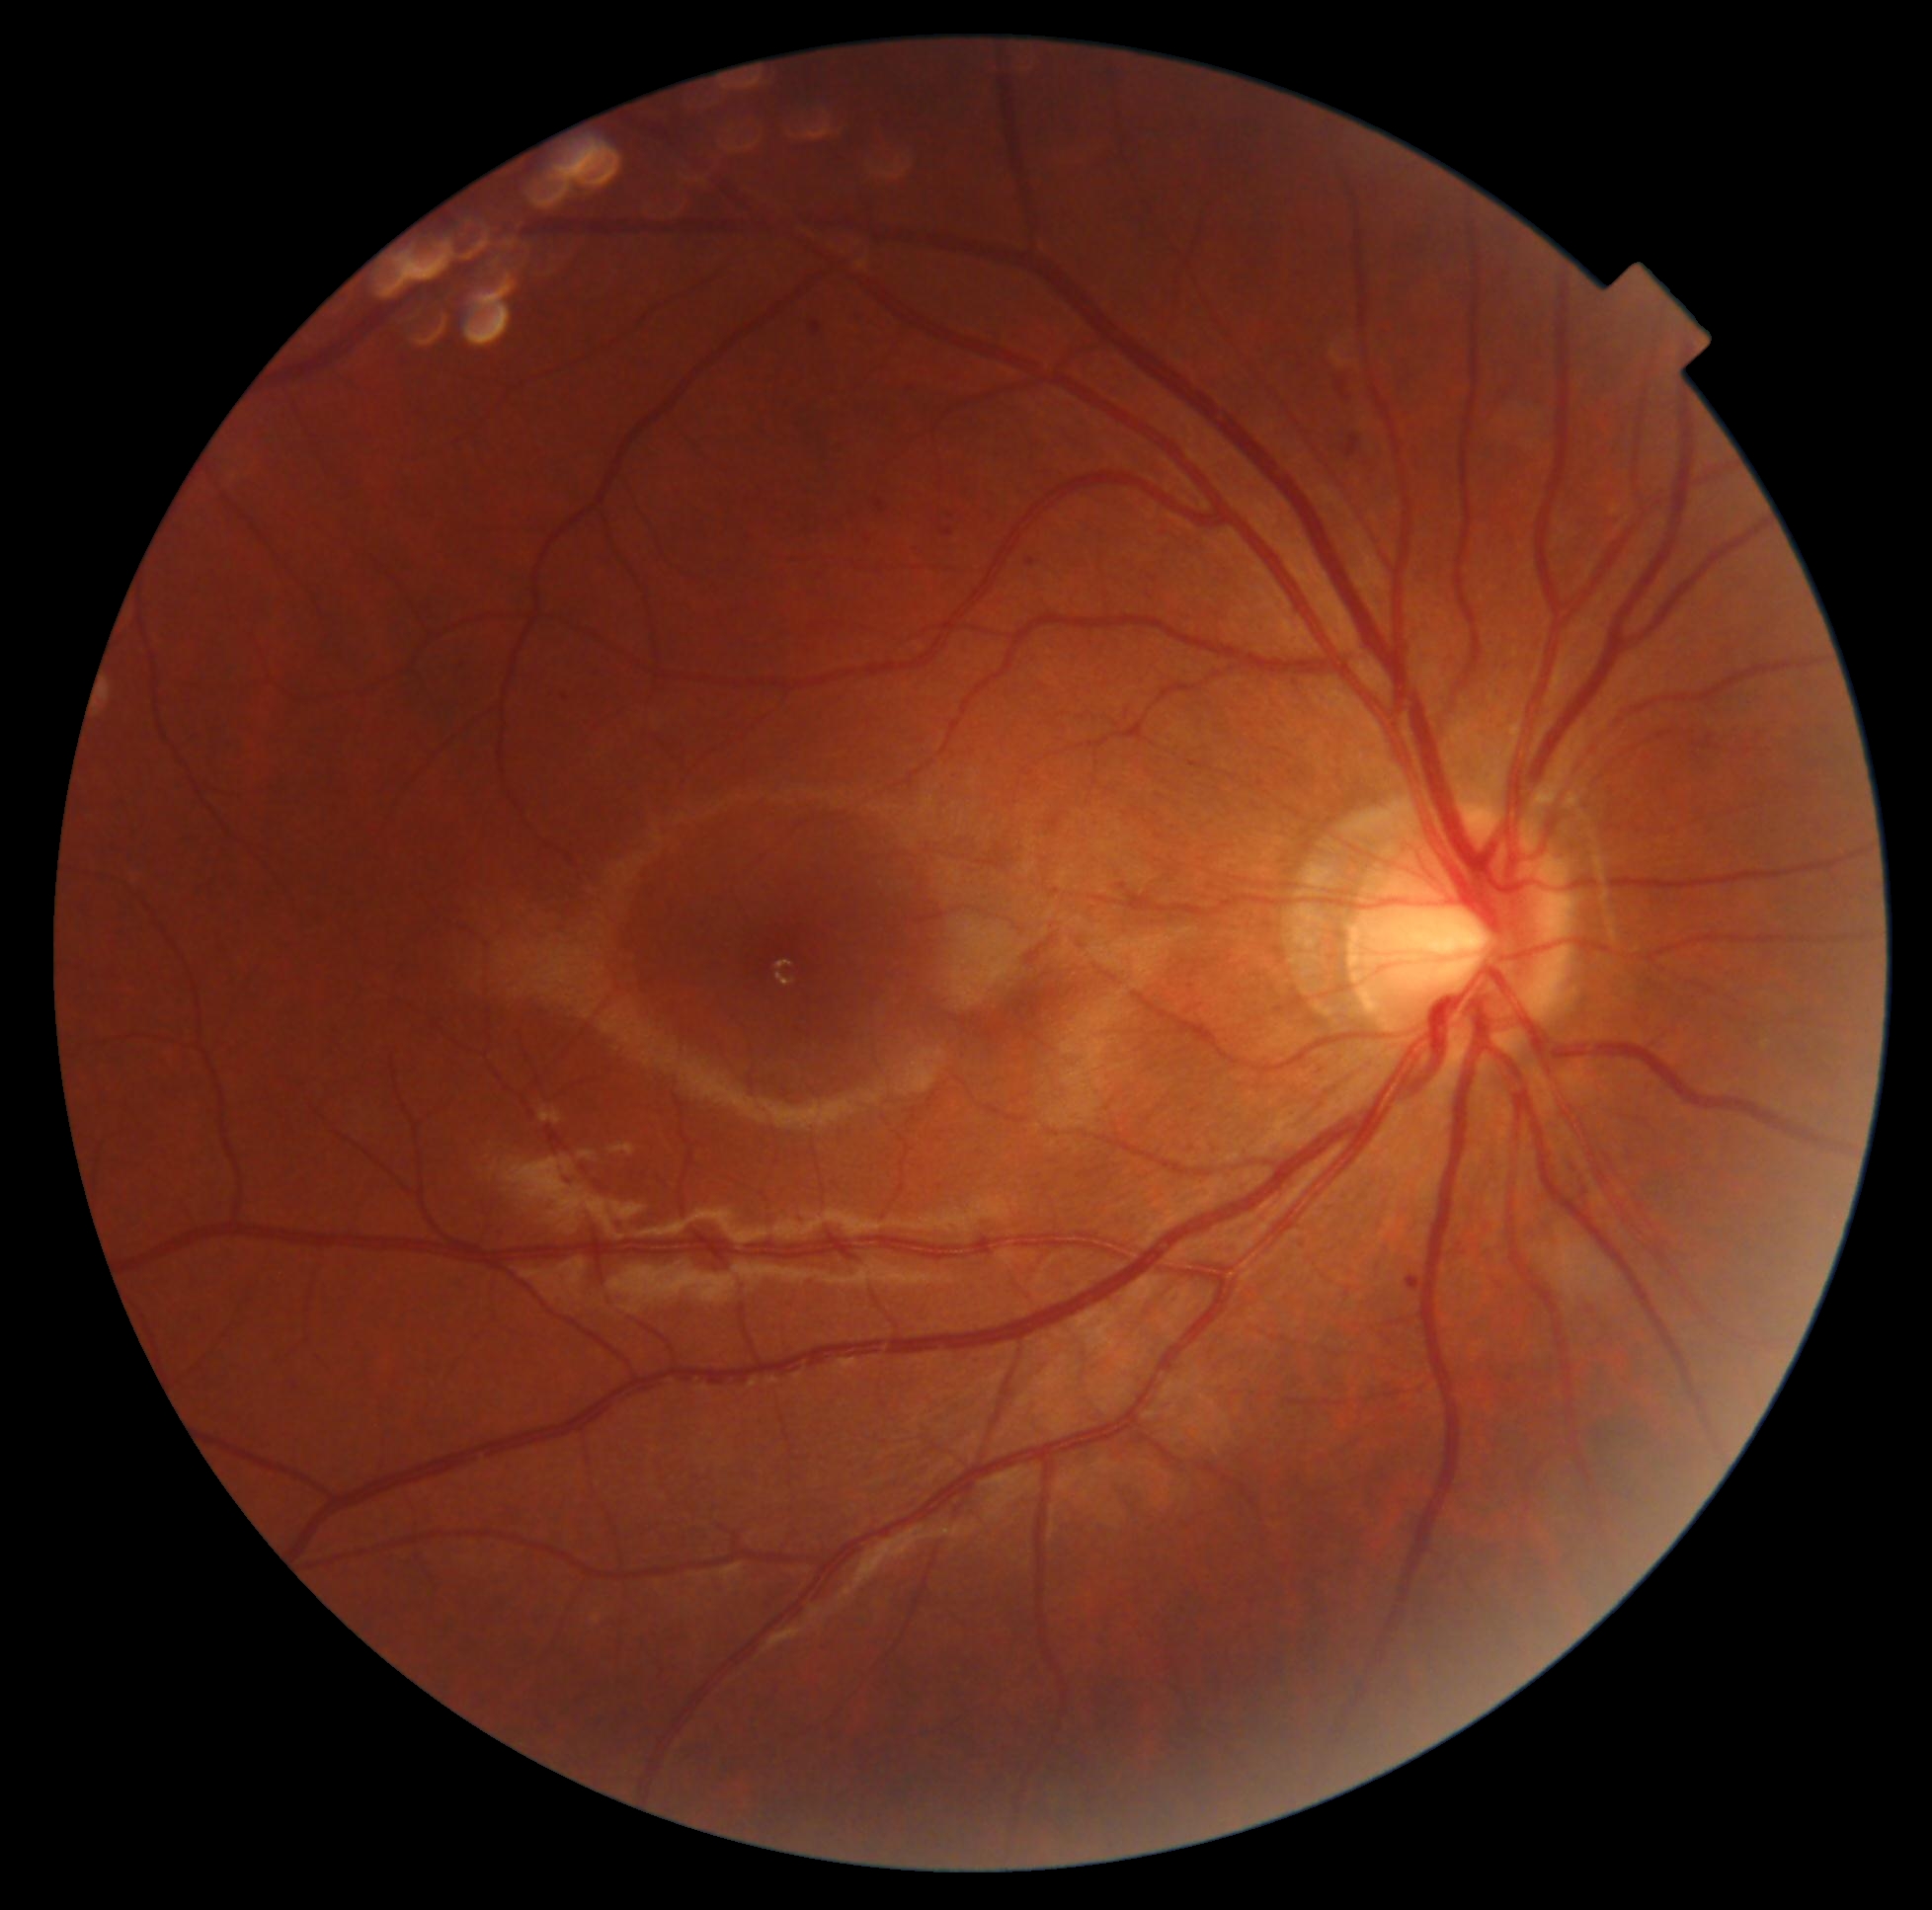
Annotations:
– diabetic retinopathy severity — moderate NPDR (grade 2)